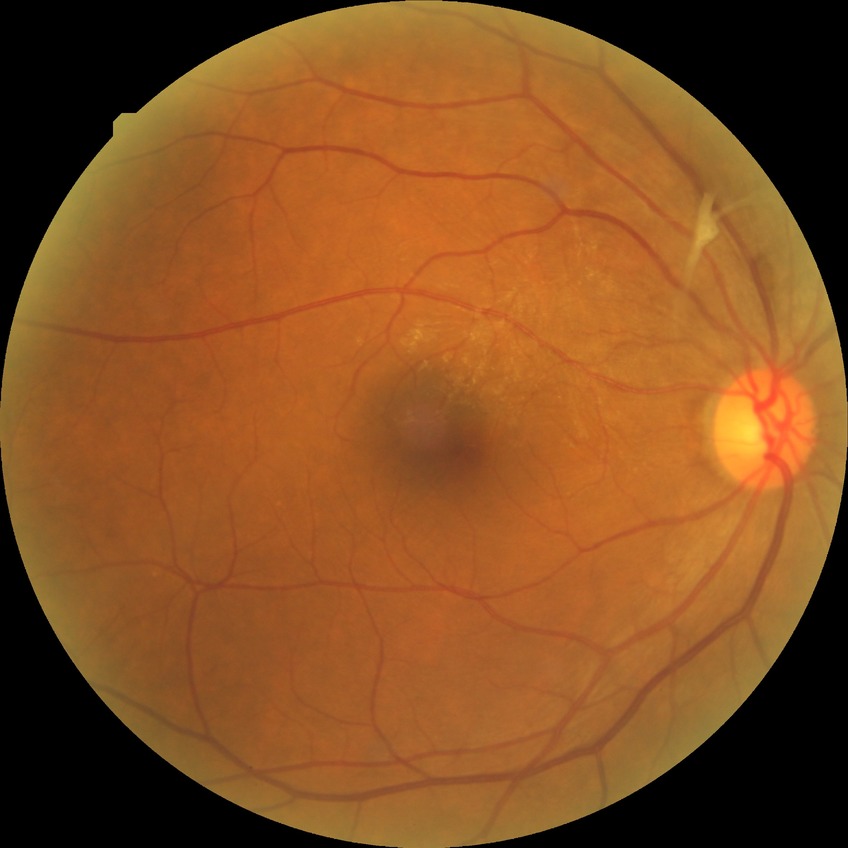

Diabetic retinopathy stage is no diabetic retinopathy.